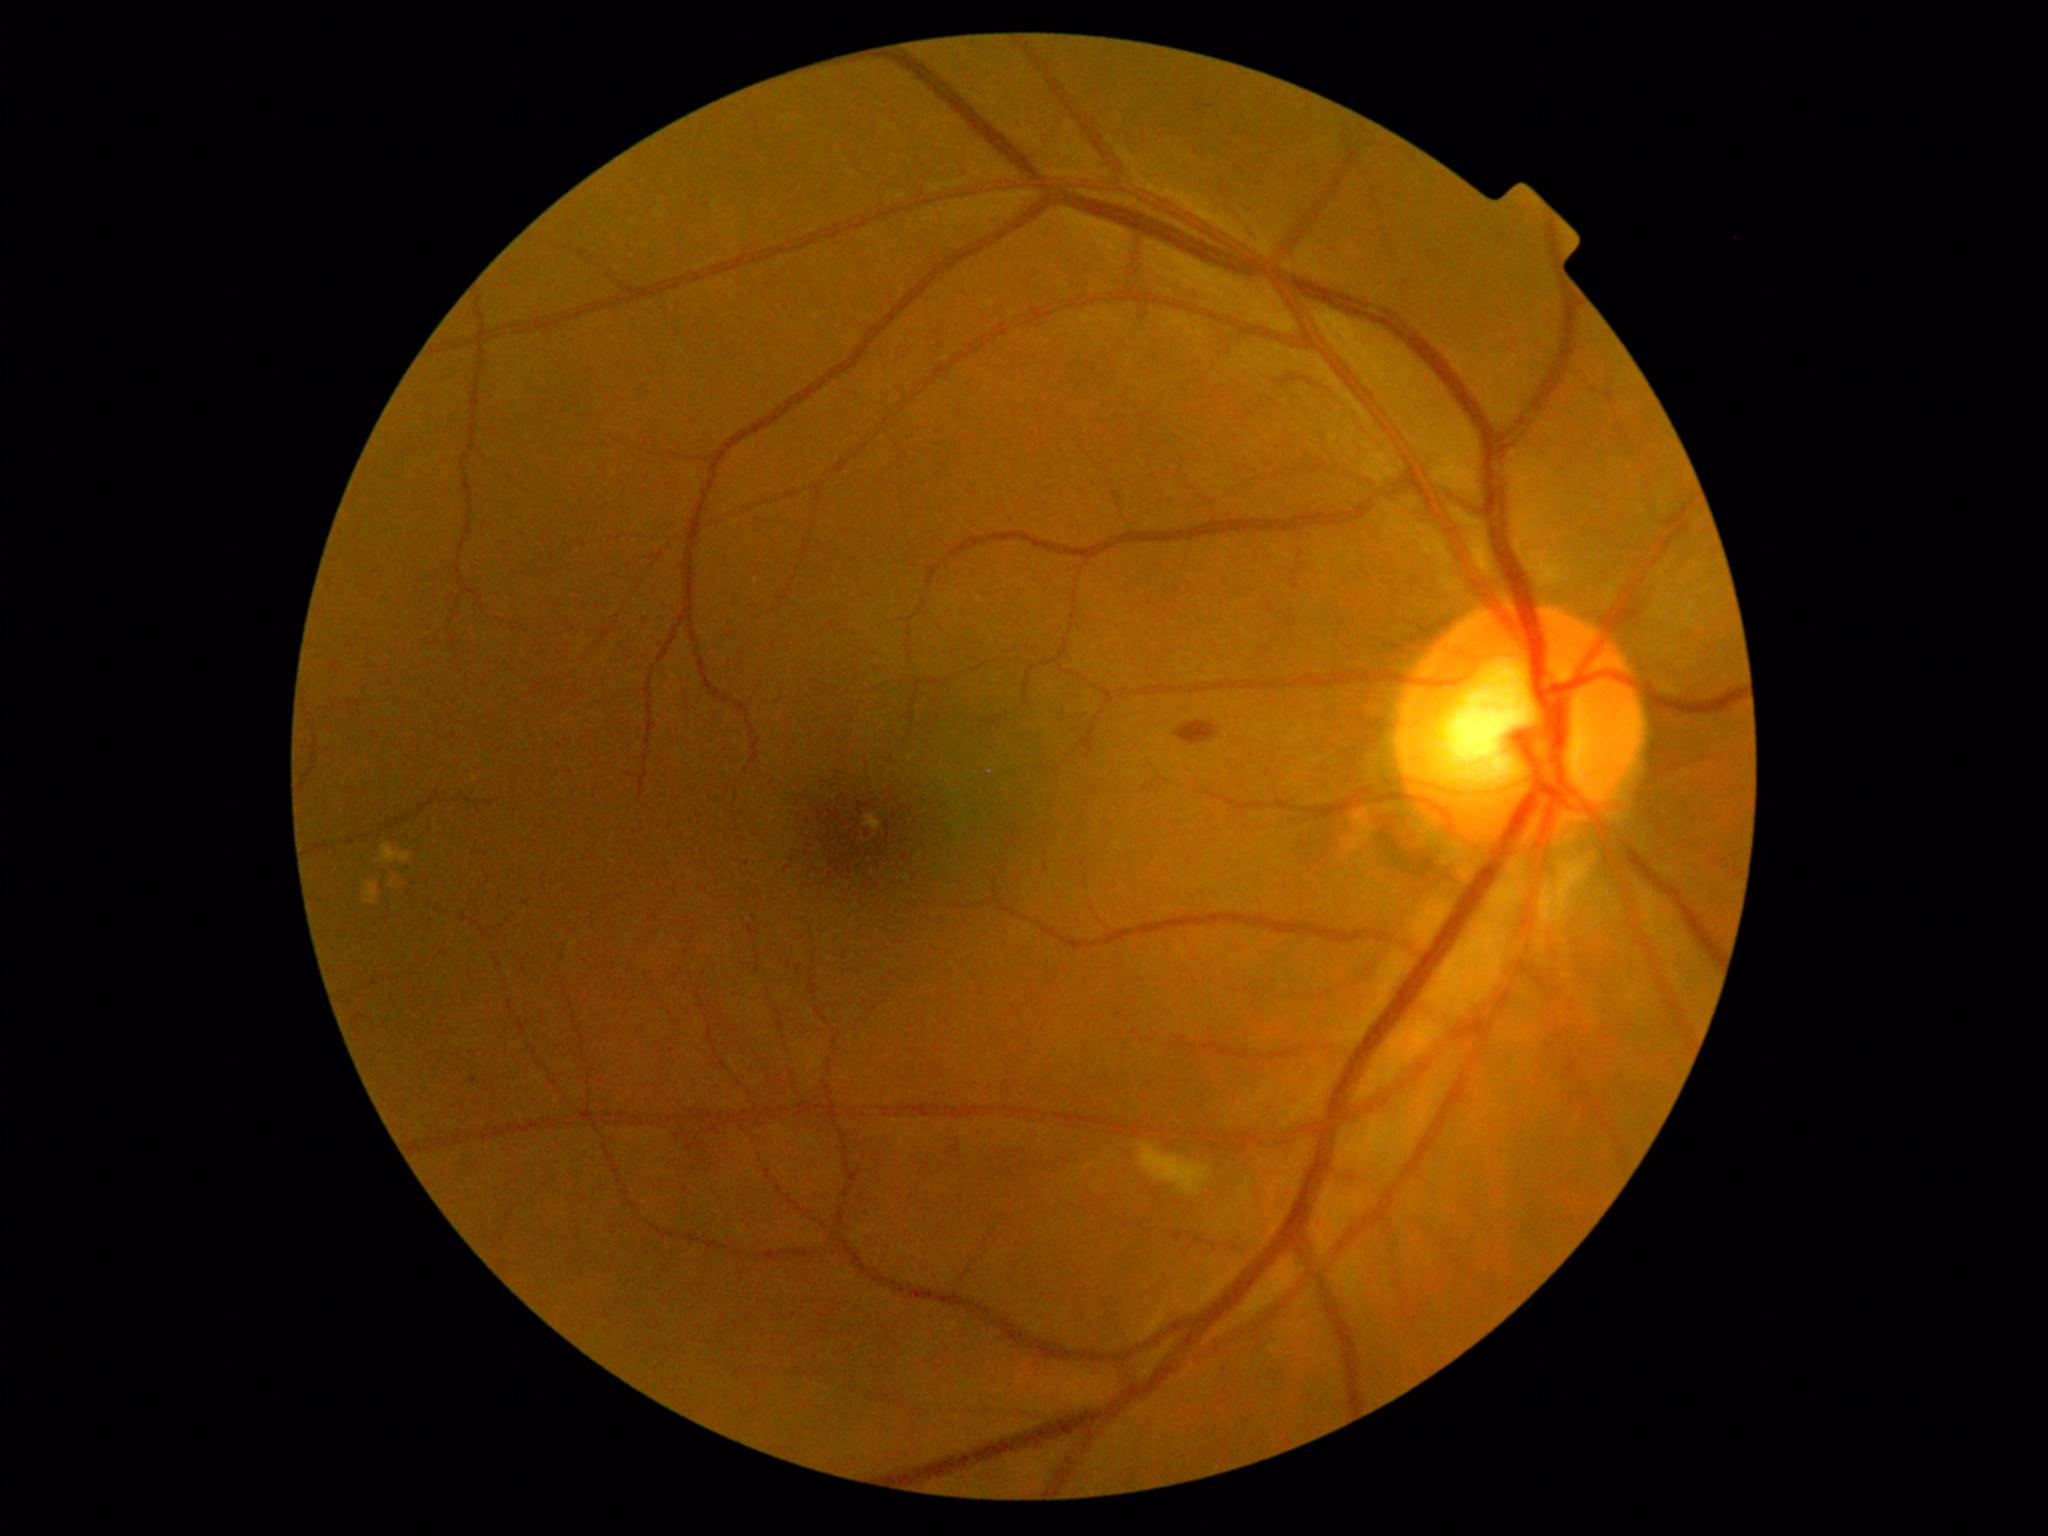 dr_grade: 2
dr_grade_name: moderate NPDR
lesions:
  se:
    - <box>1139,1143,1211,1195</box>
  he:
    - <box>1178,722,1218,745</box>
    - <box>944,1142,970,1168</box>
    - <box>671,1128,716,1168</box>
  ma: []
  ex: []